CFP:
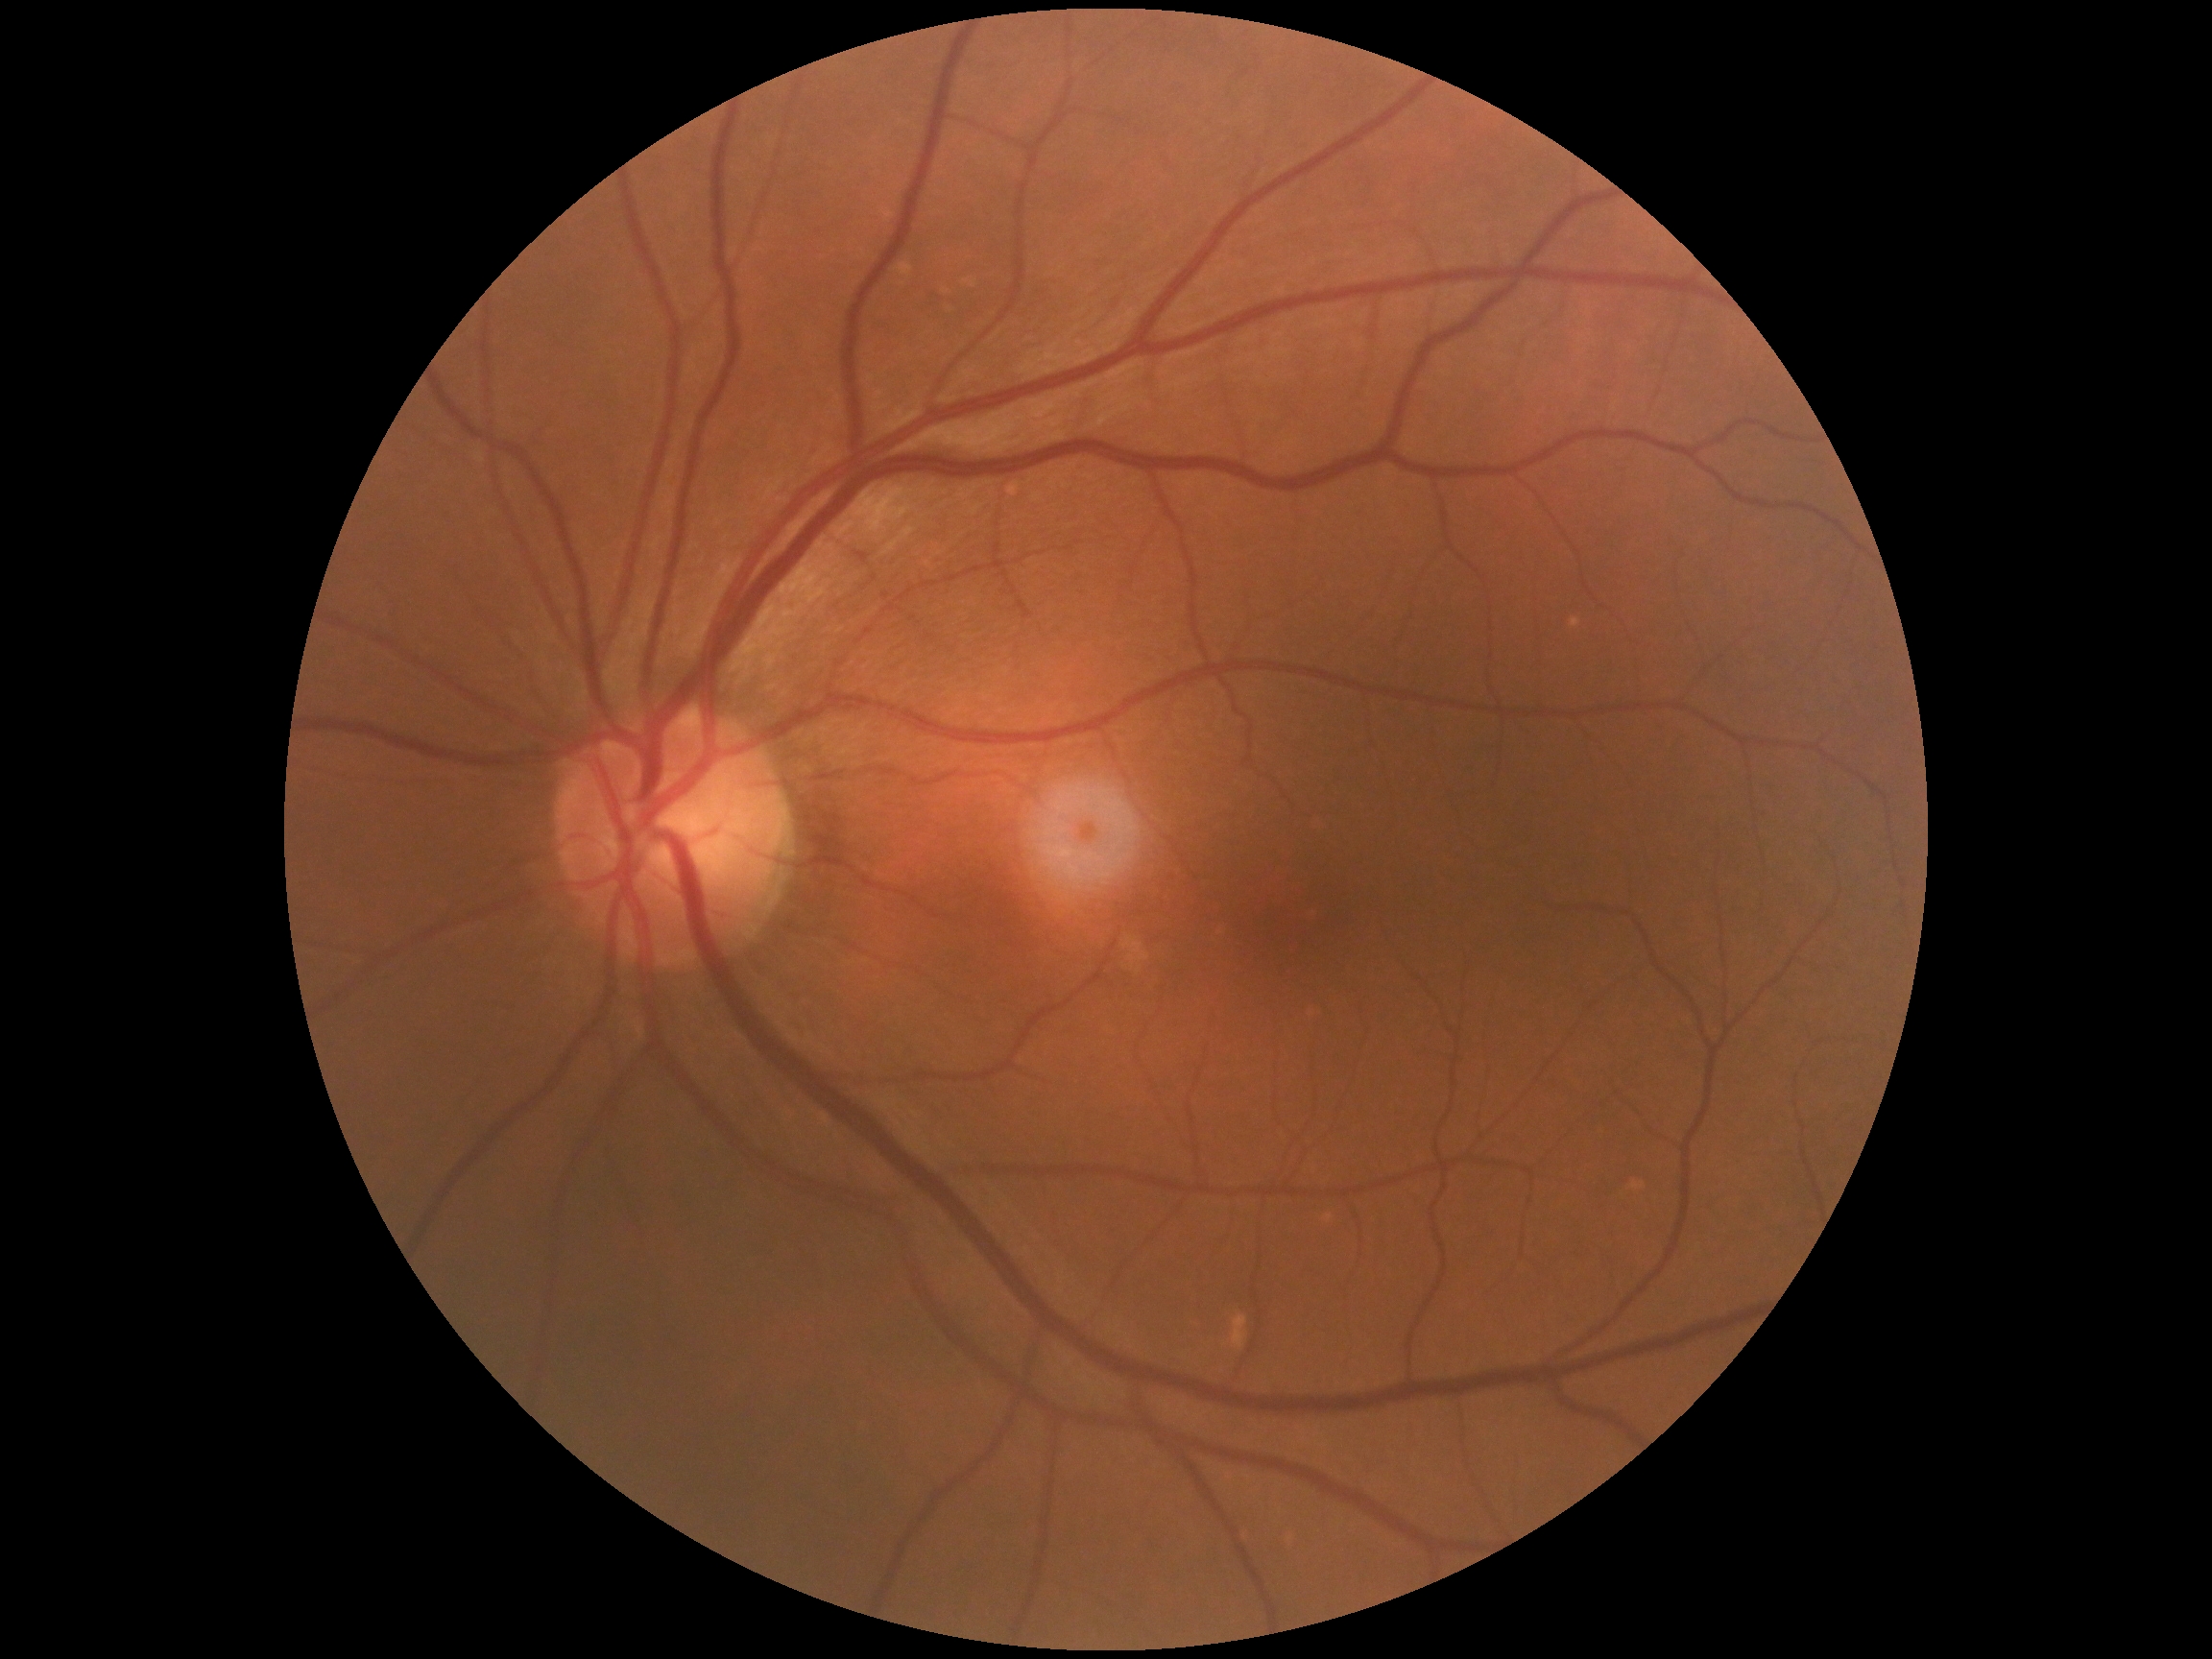

Diabetic retinopathy (DR) is 0/4.
No apparent diabetic retinopathy.